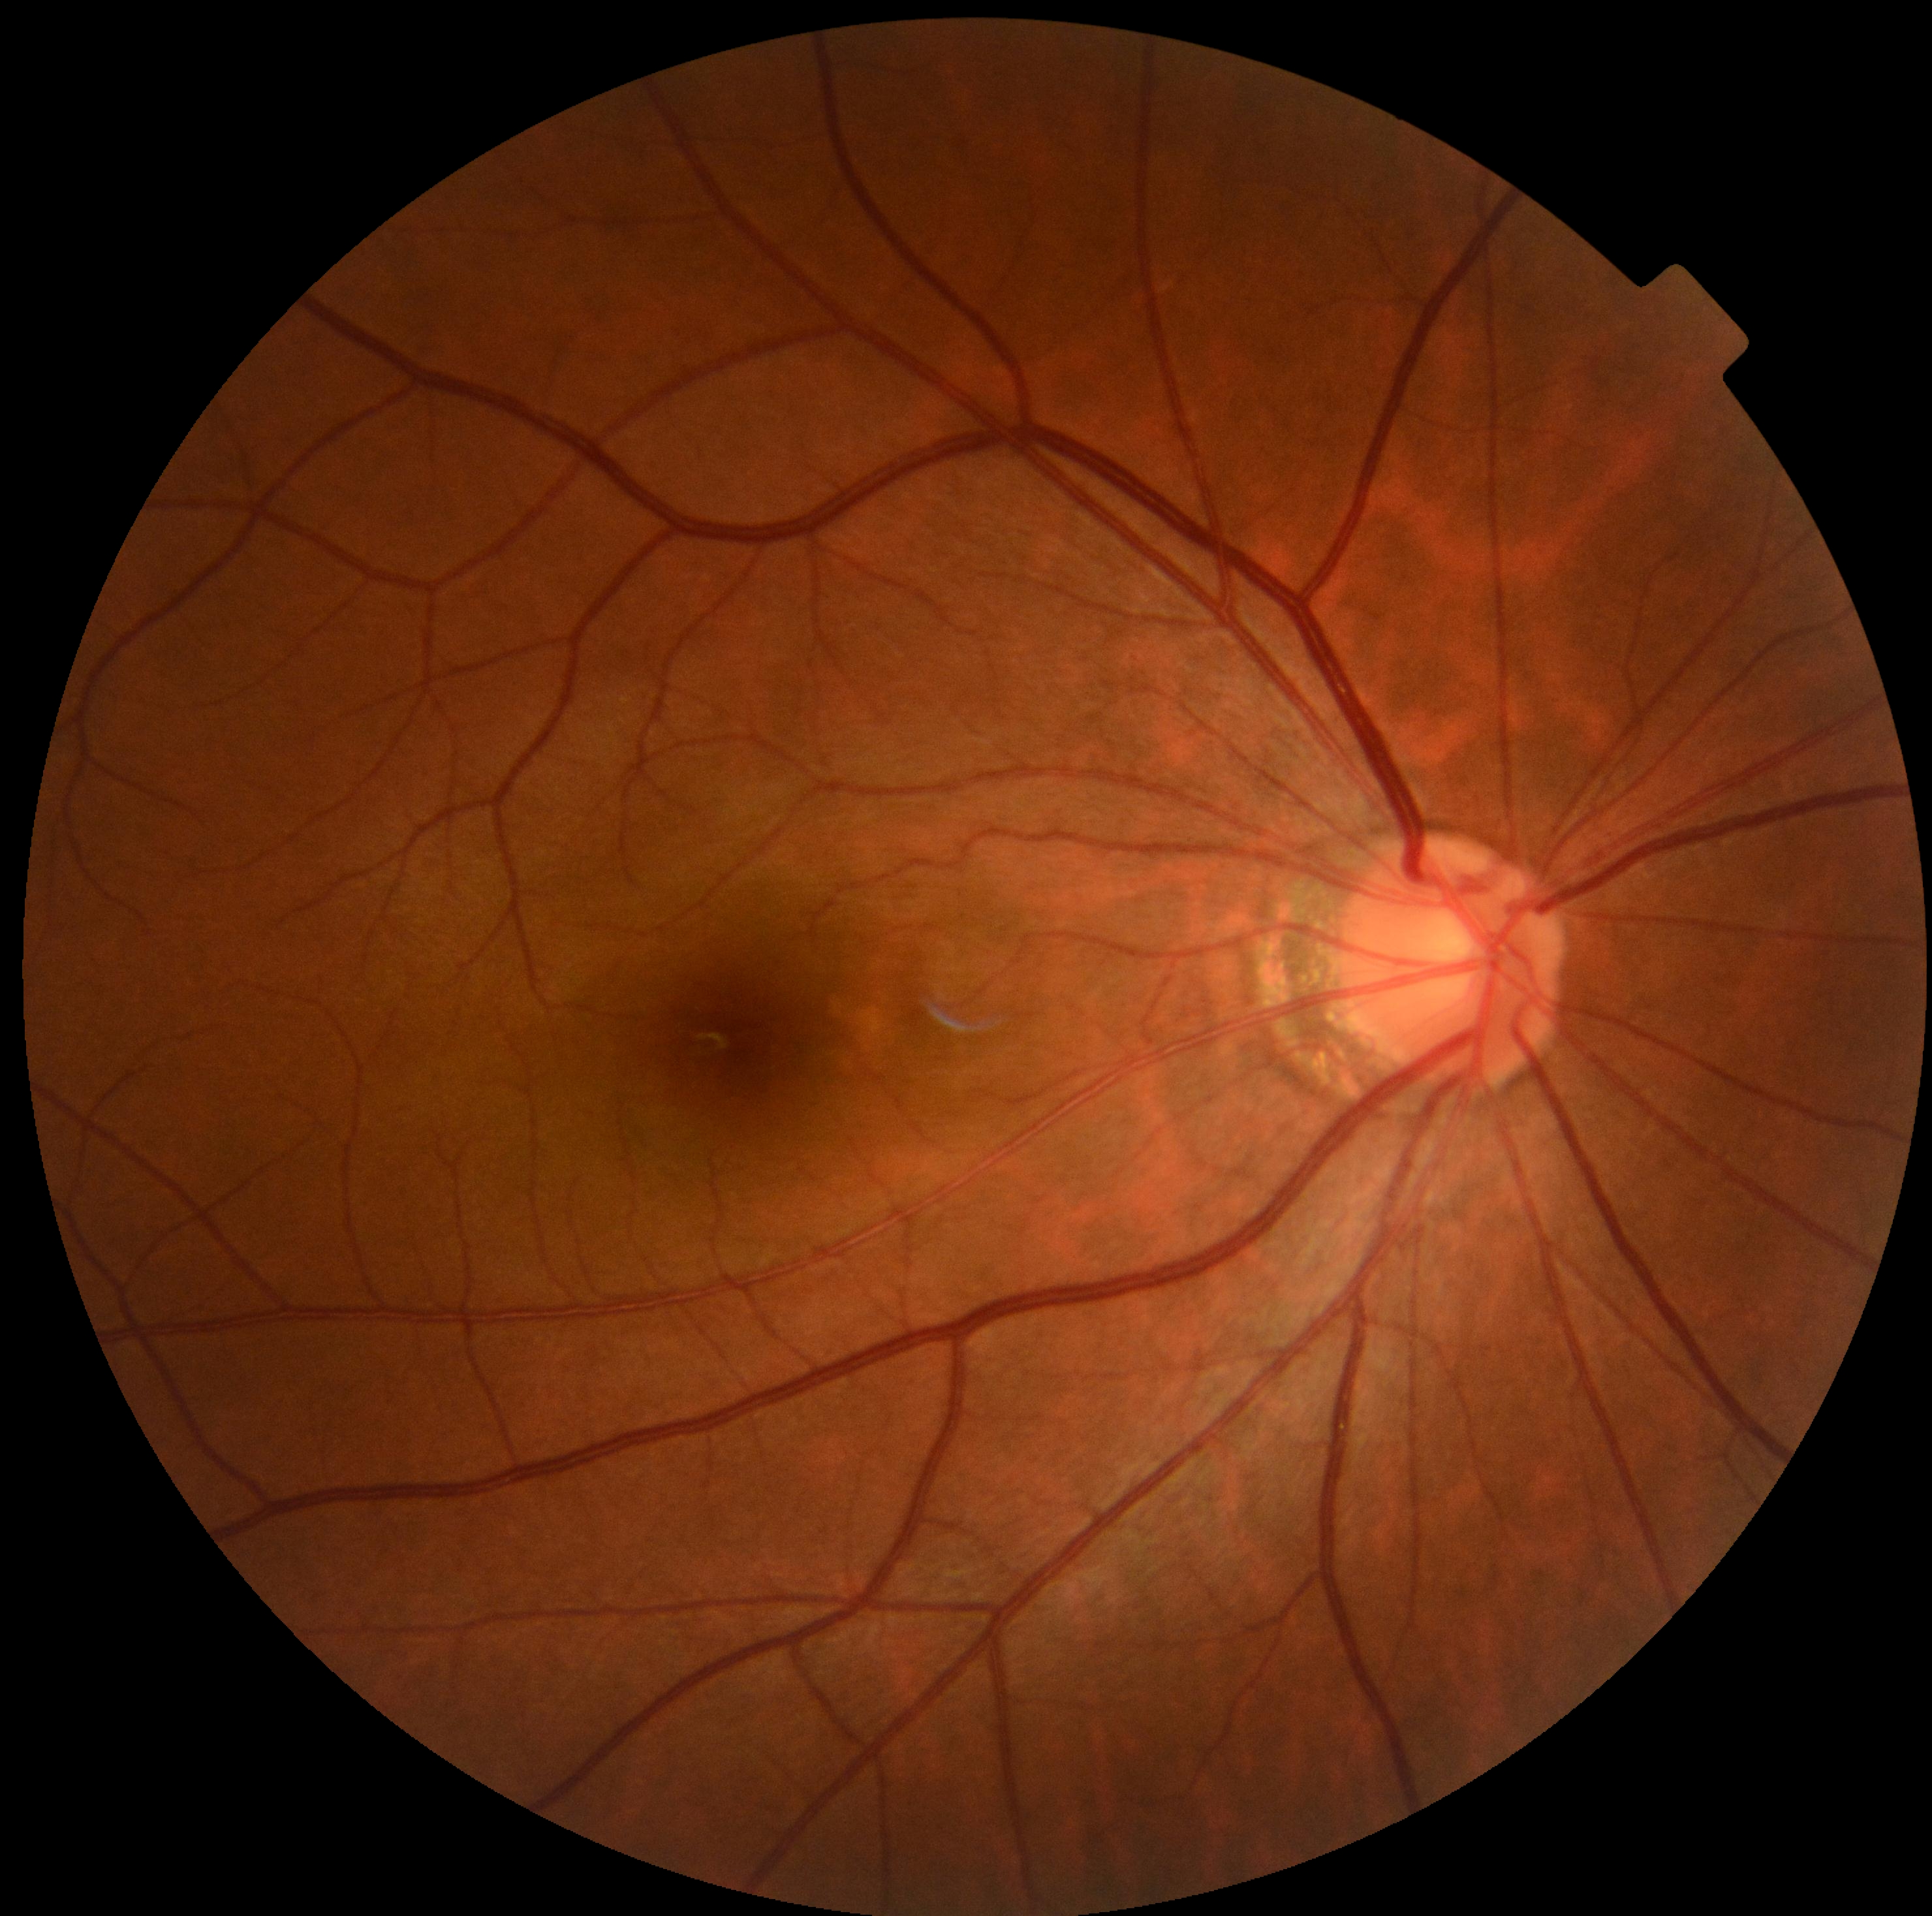
DR is 0.